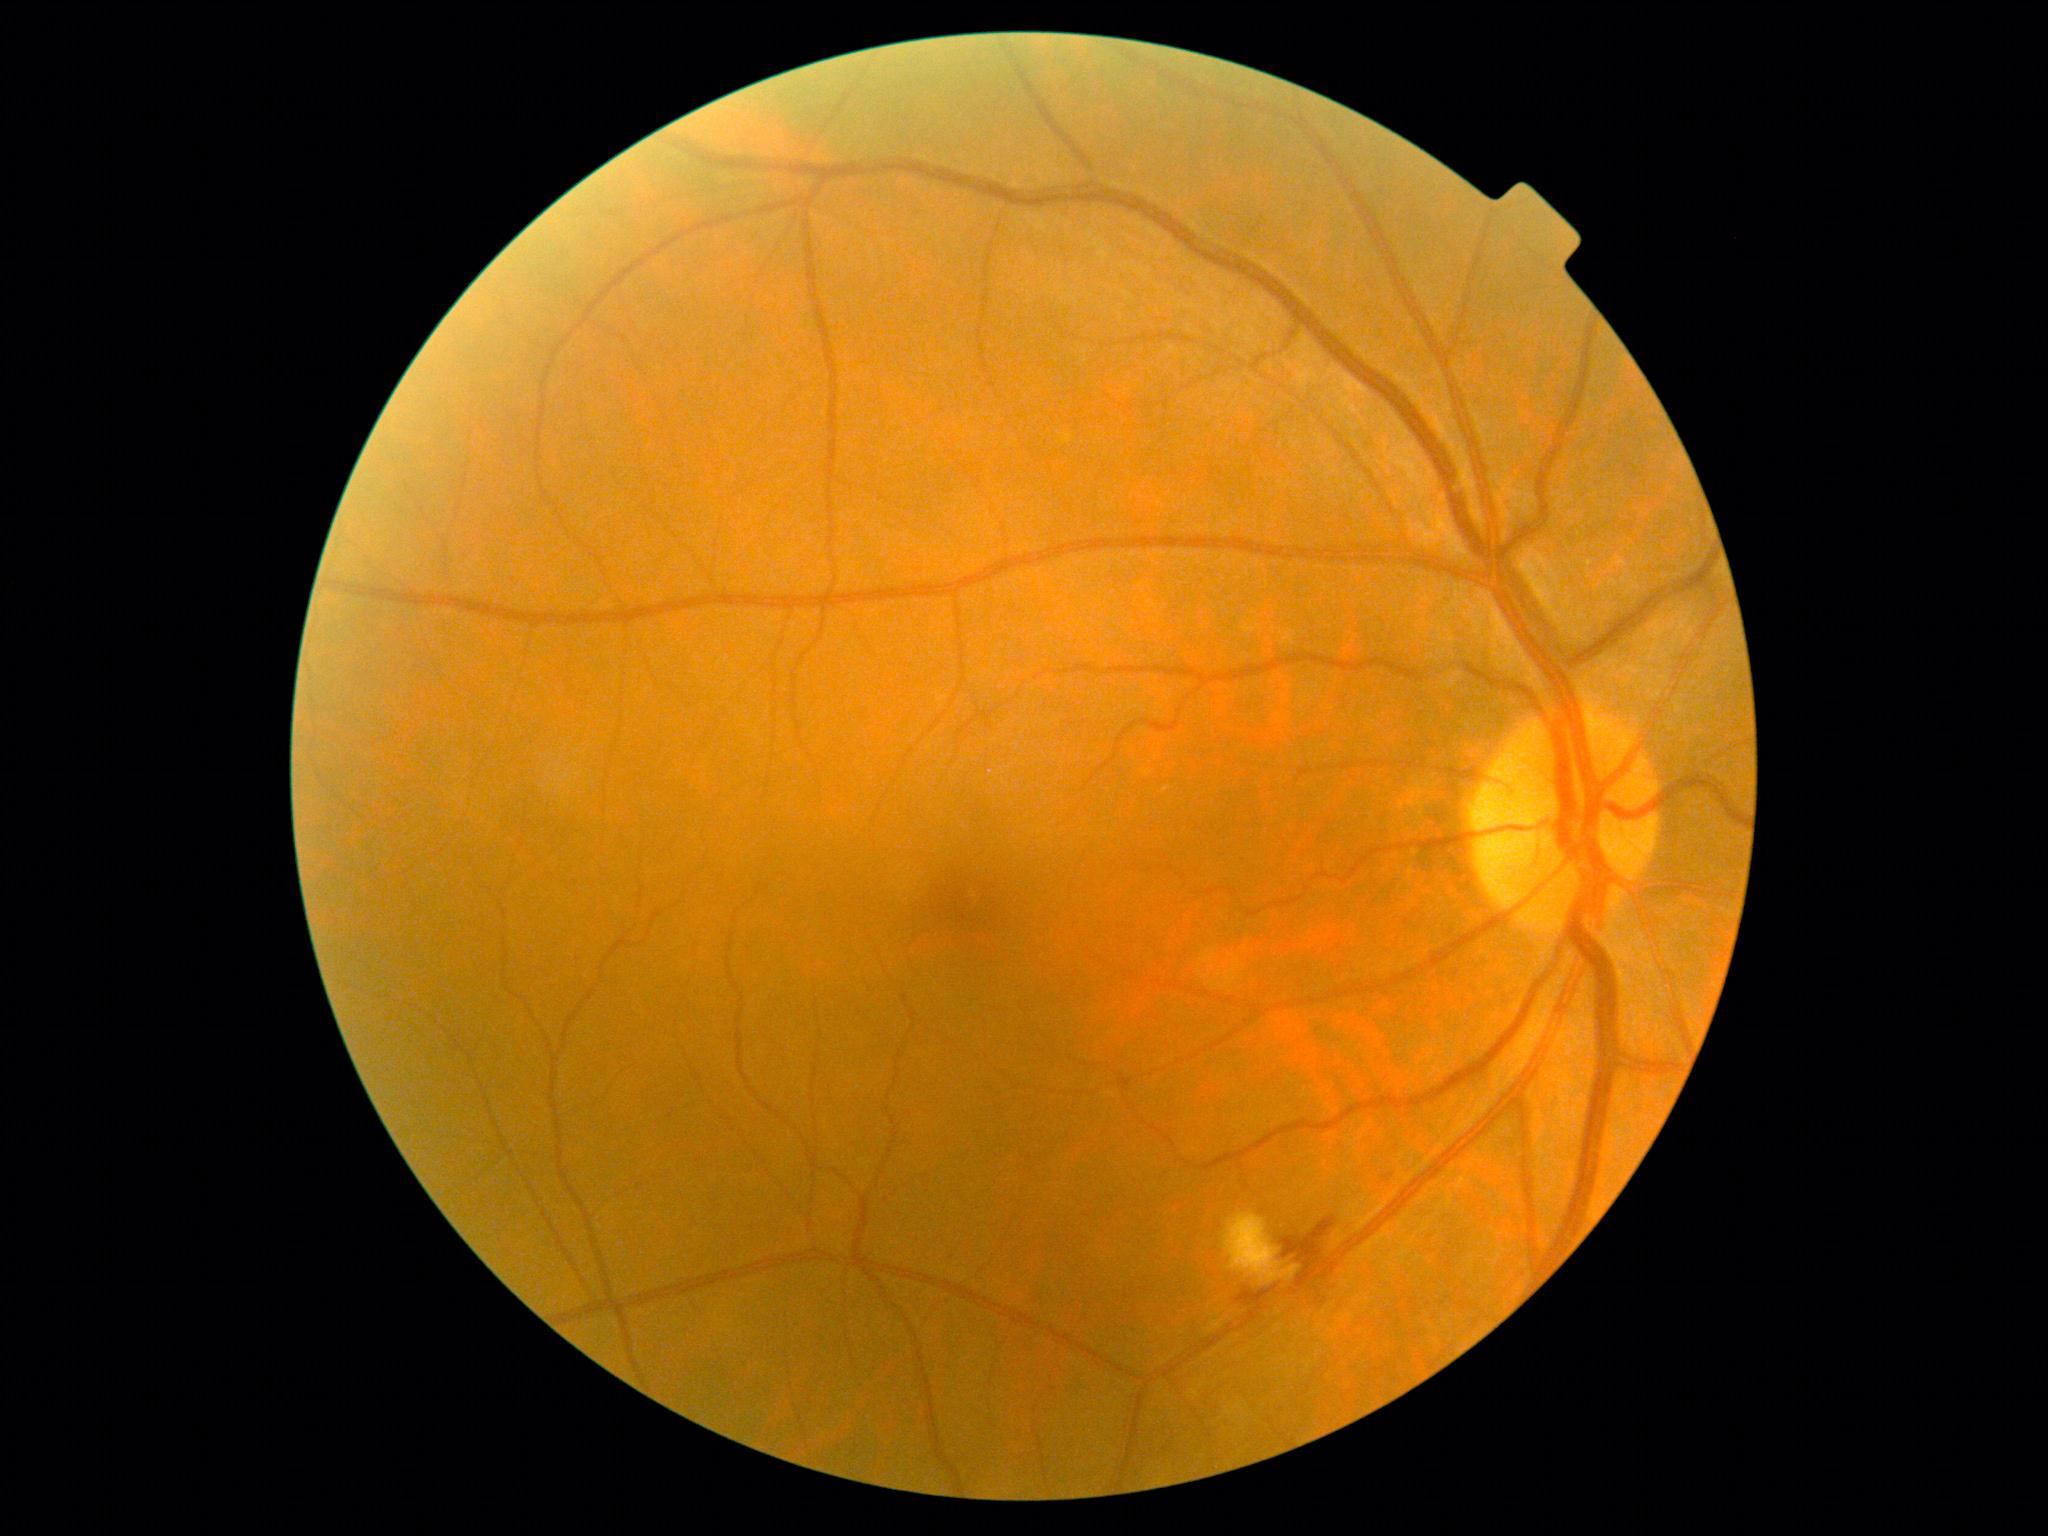
Annotations:
• DR grade — moderate non-proliferative diabetic retinopathy (2)